Image size 1240x1240 · camera: Phoenix ICON (100° FOV) · wide-field fundus photograph of an infant
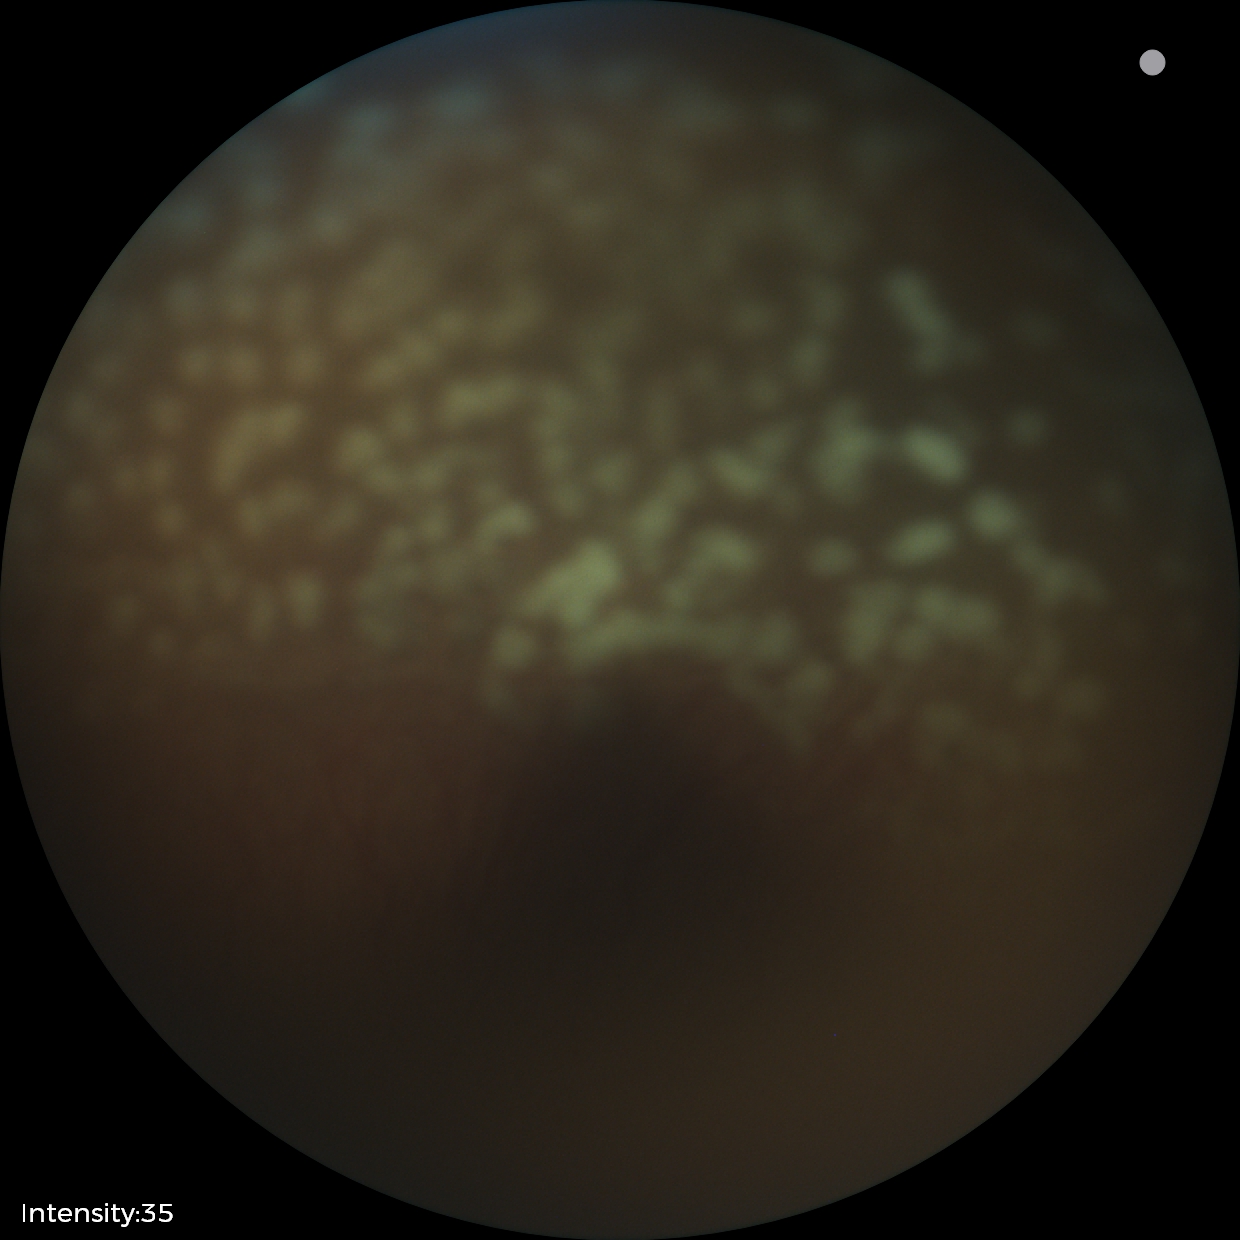
With plus disease. From an examination with diagnosis of retinopathy of prematurity stage 2.